Pediatric retinal photograph (wide-field). Captured with the Clarity RetCam 3 (130° field of view). 640x480:
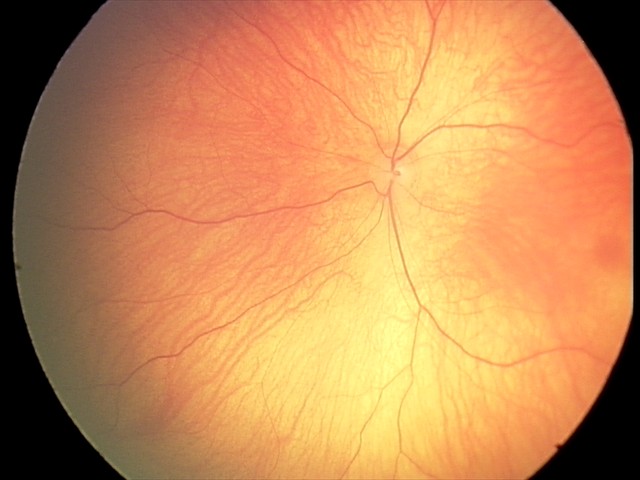 Screening examination diagnosed as physiological.